Color fundus image:
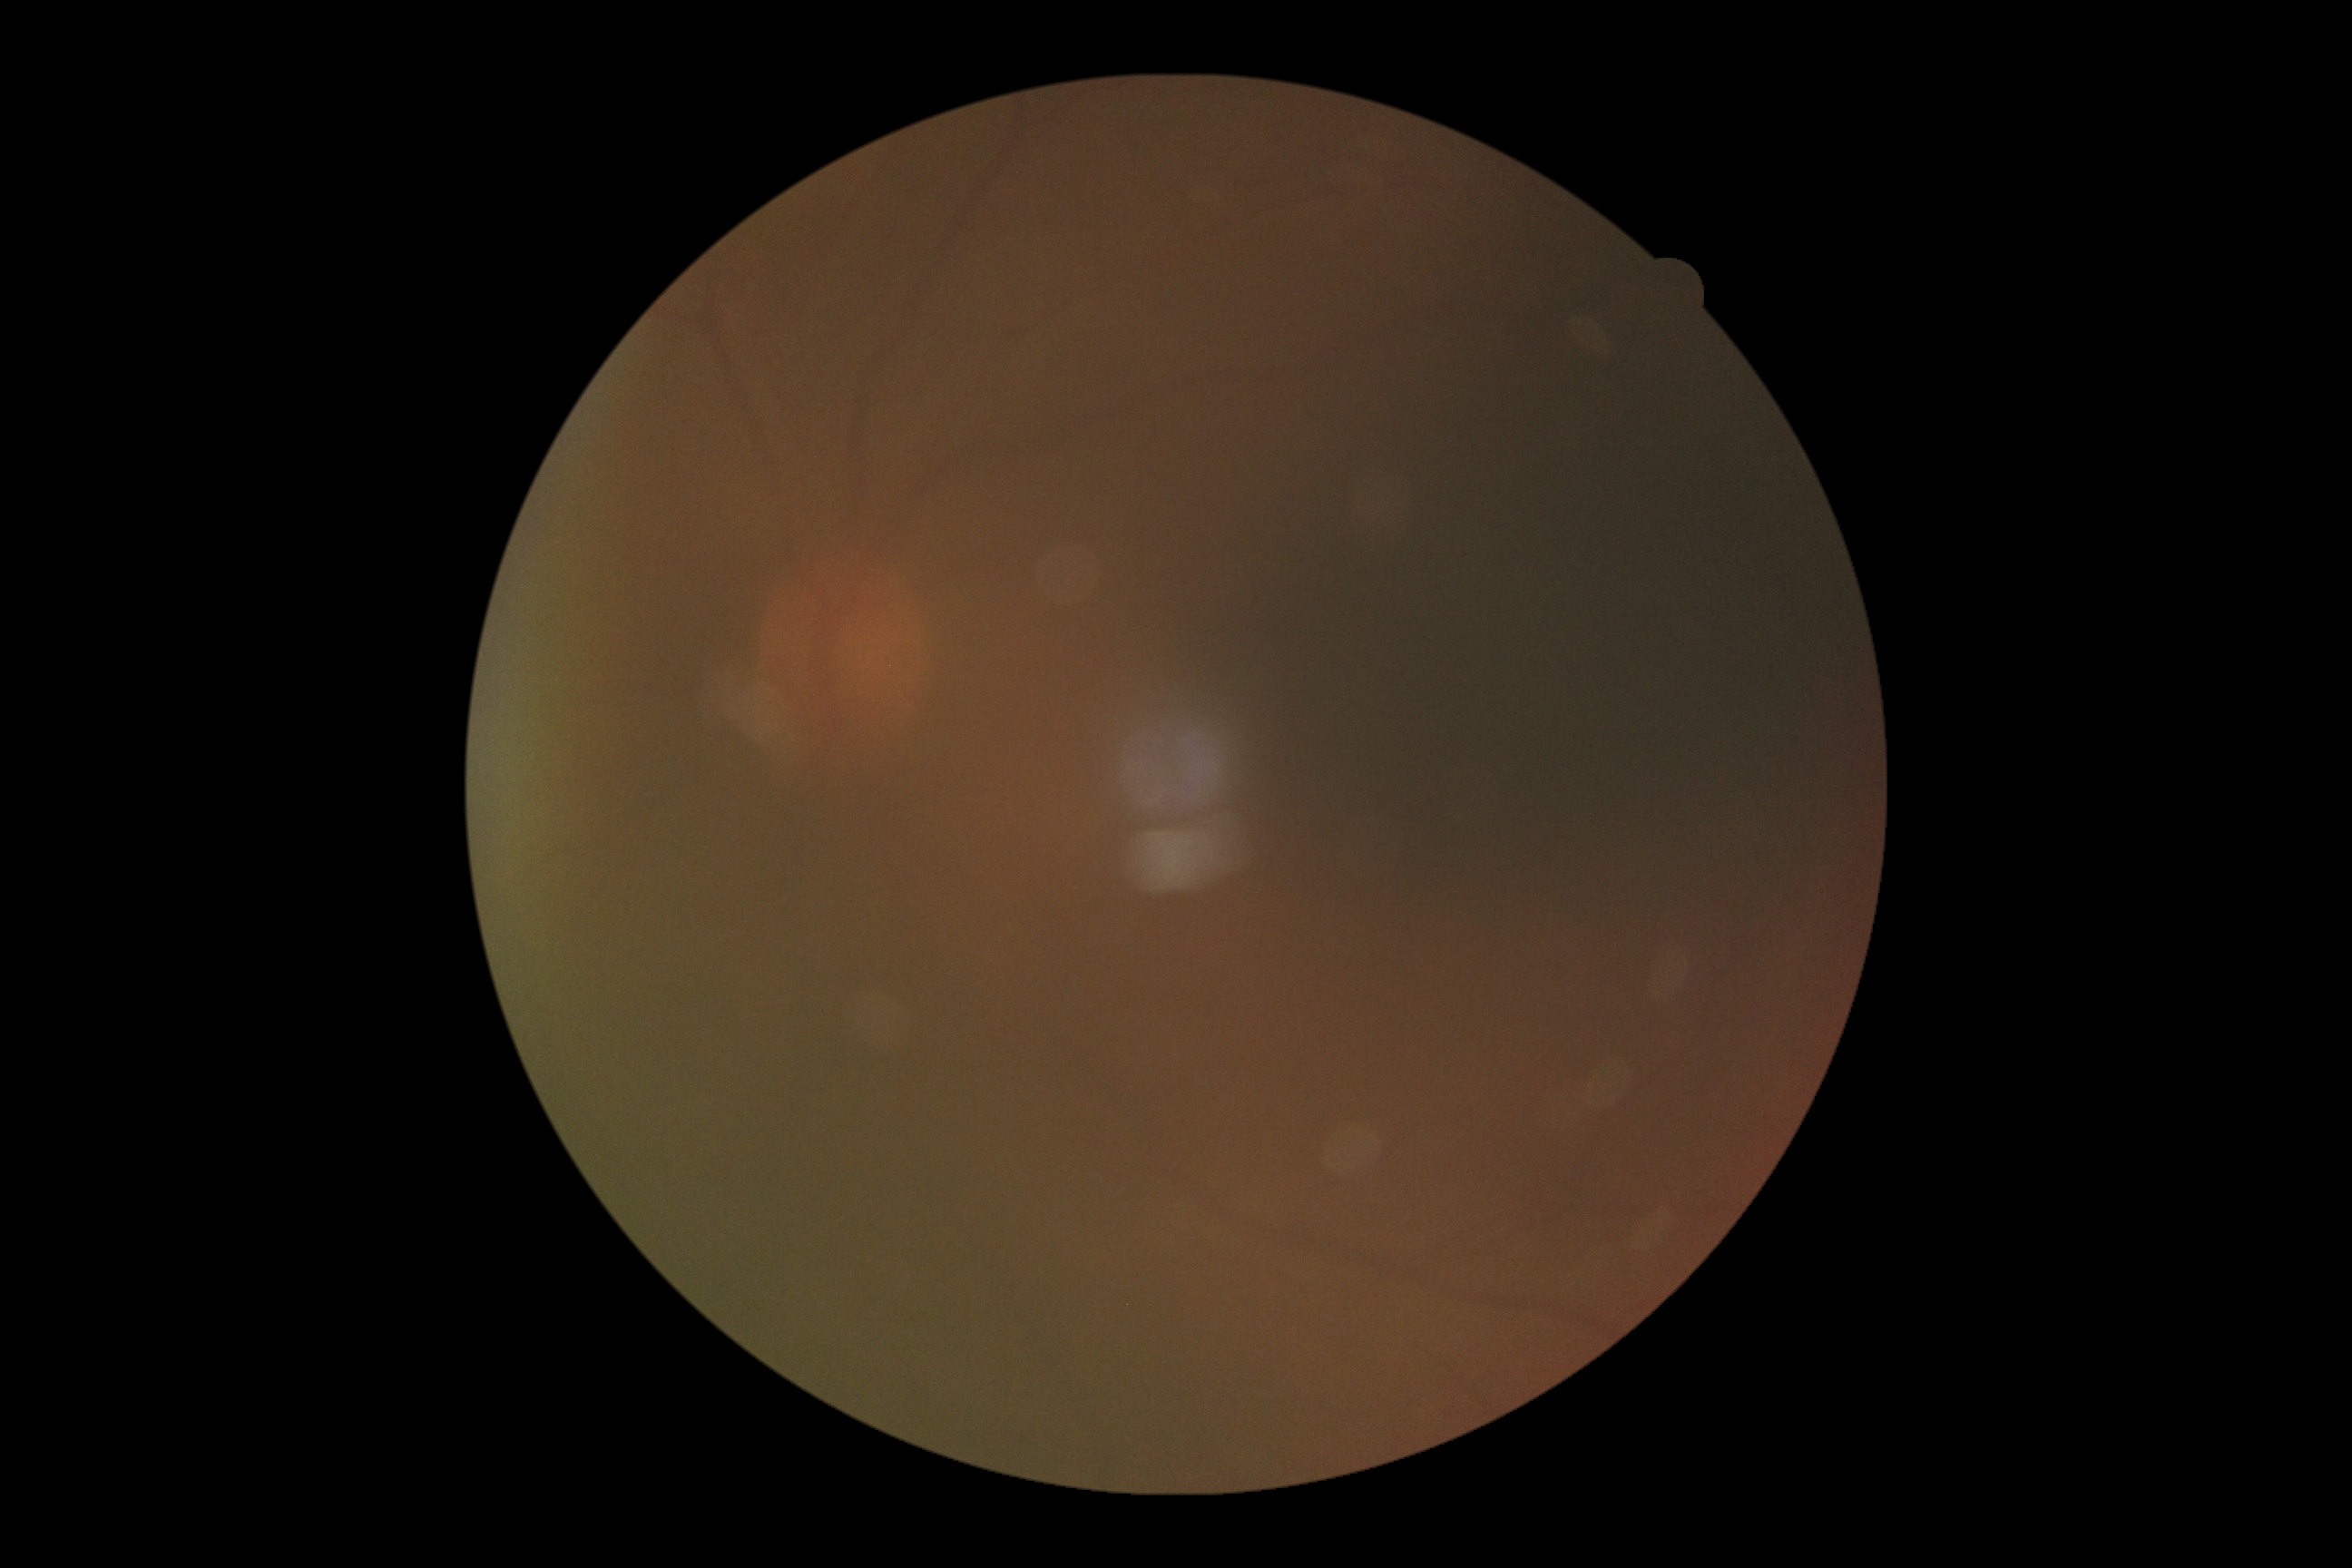

diabetic retinopathy grade = ungradable
image quality = below grading threshold